Color fundus photograph. Modified Davis classification. NIDEK AFC-230 fundus camera: 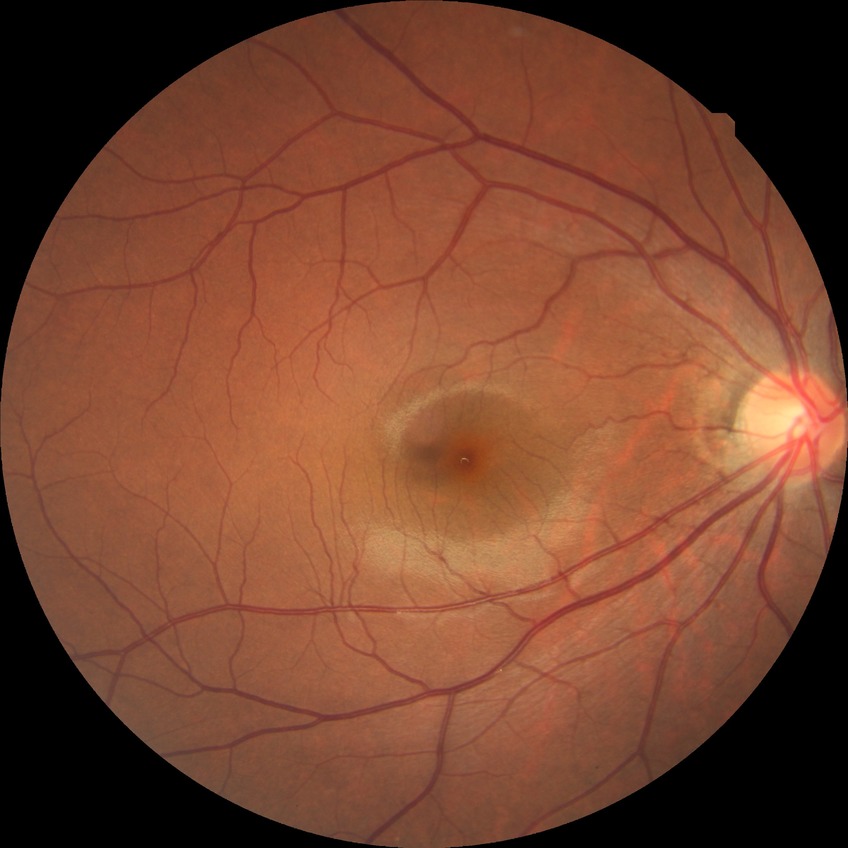 Diabetic retinopathy (DR): NDR (no diabetic retinopathy).